Pediatric wide-field fundus photograph. 640x480: 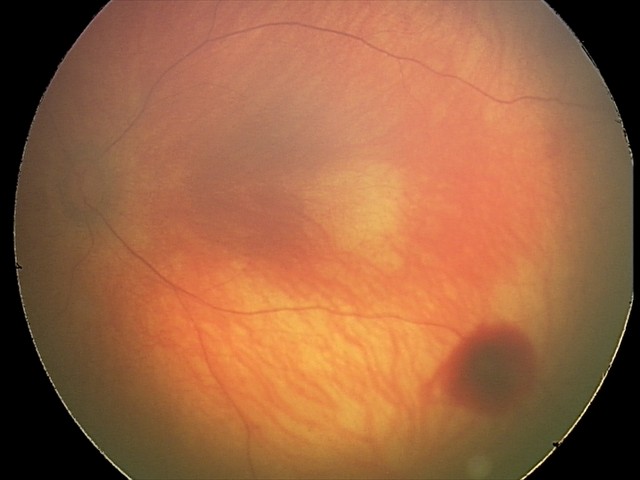 Diagnosis = retinal hemorrhages.